Fundus photo, 2089x1764px — 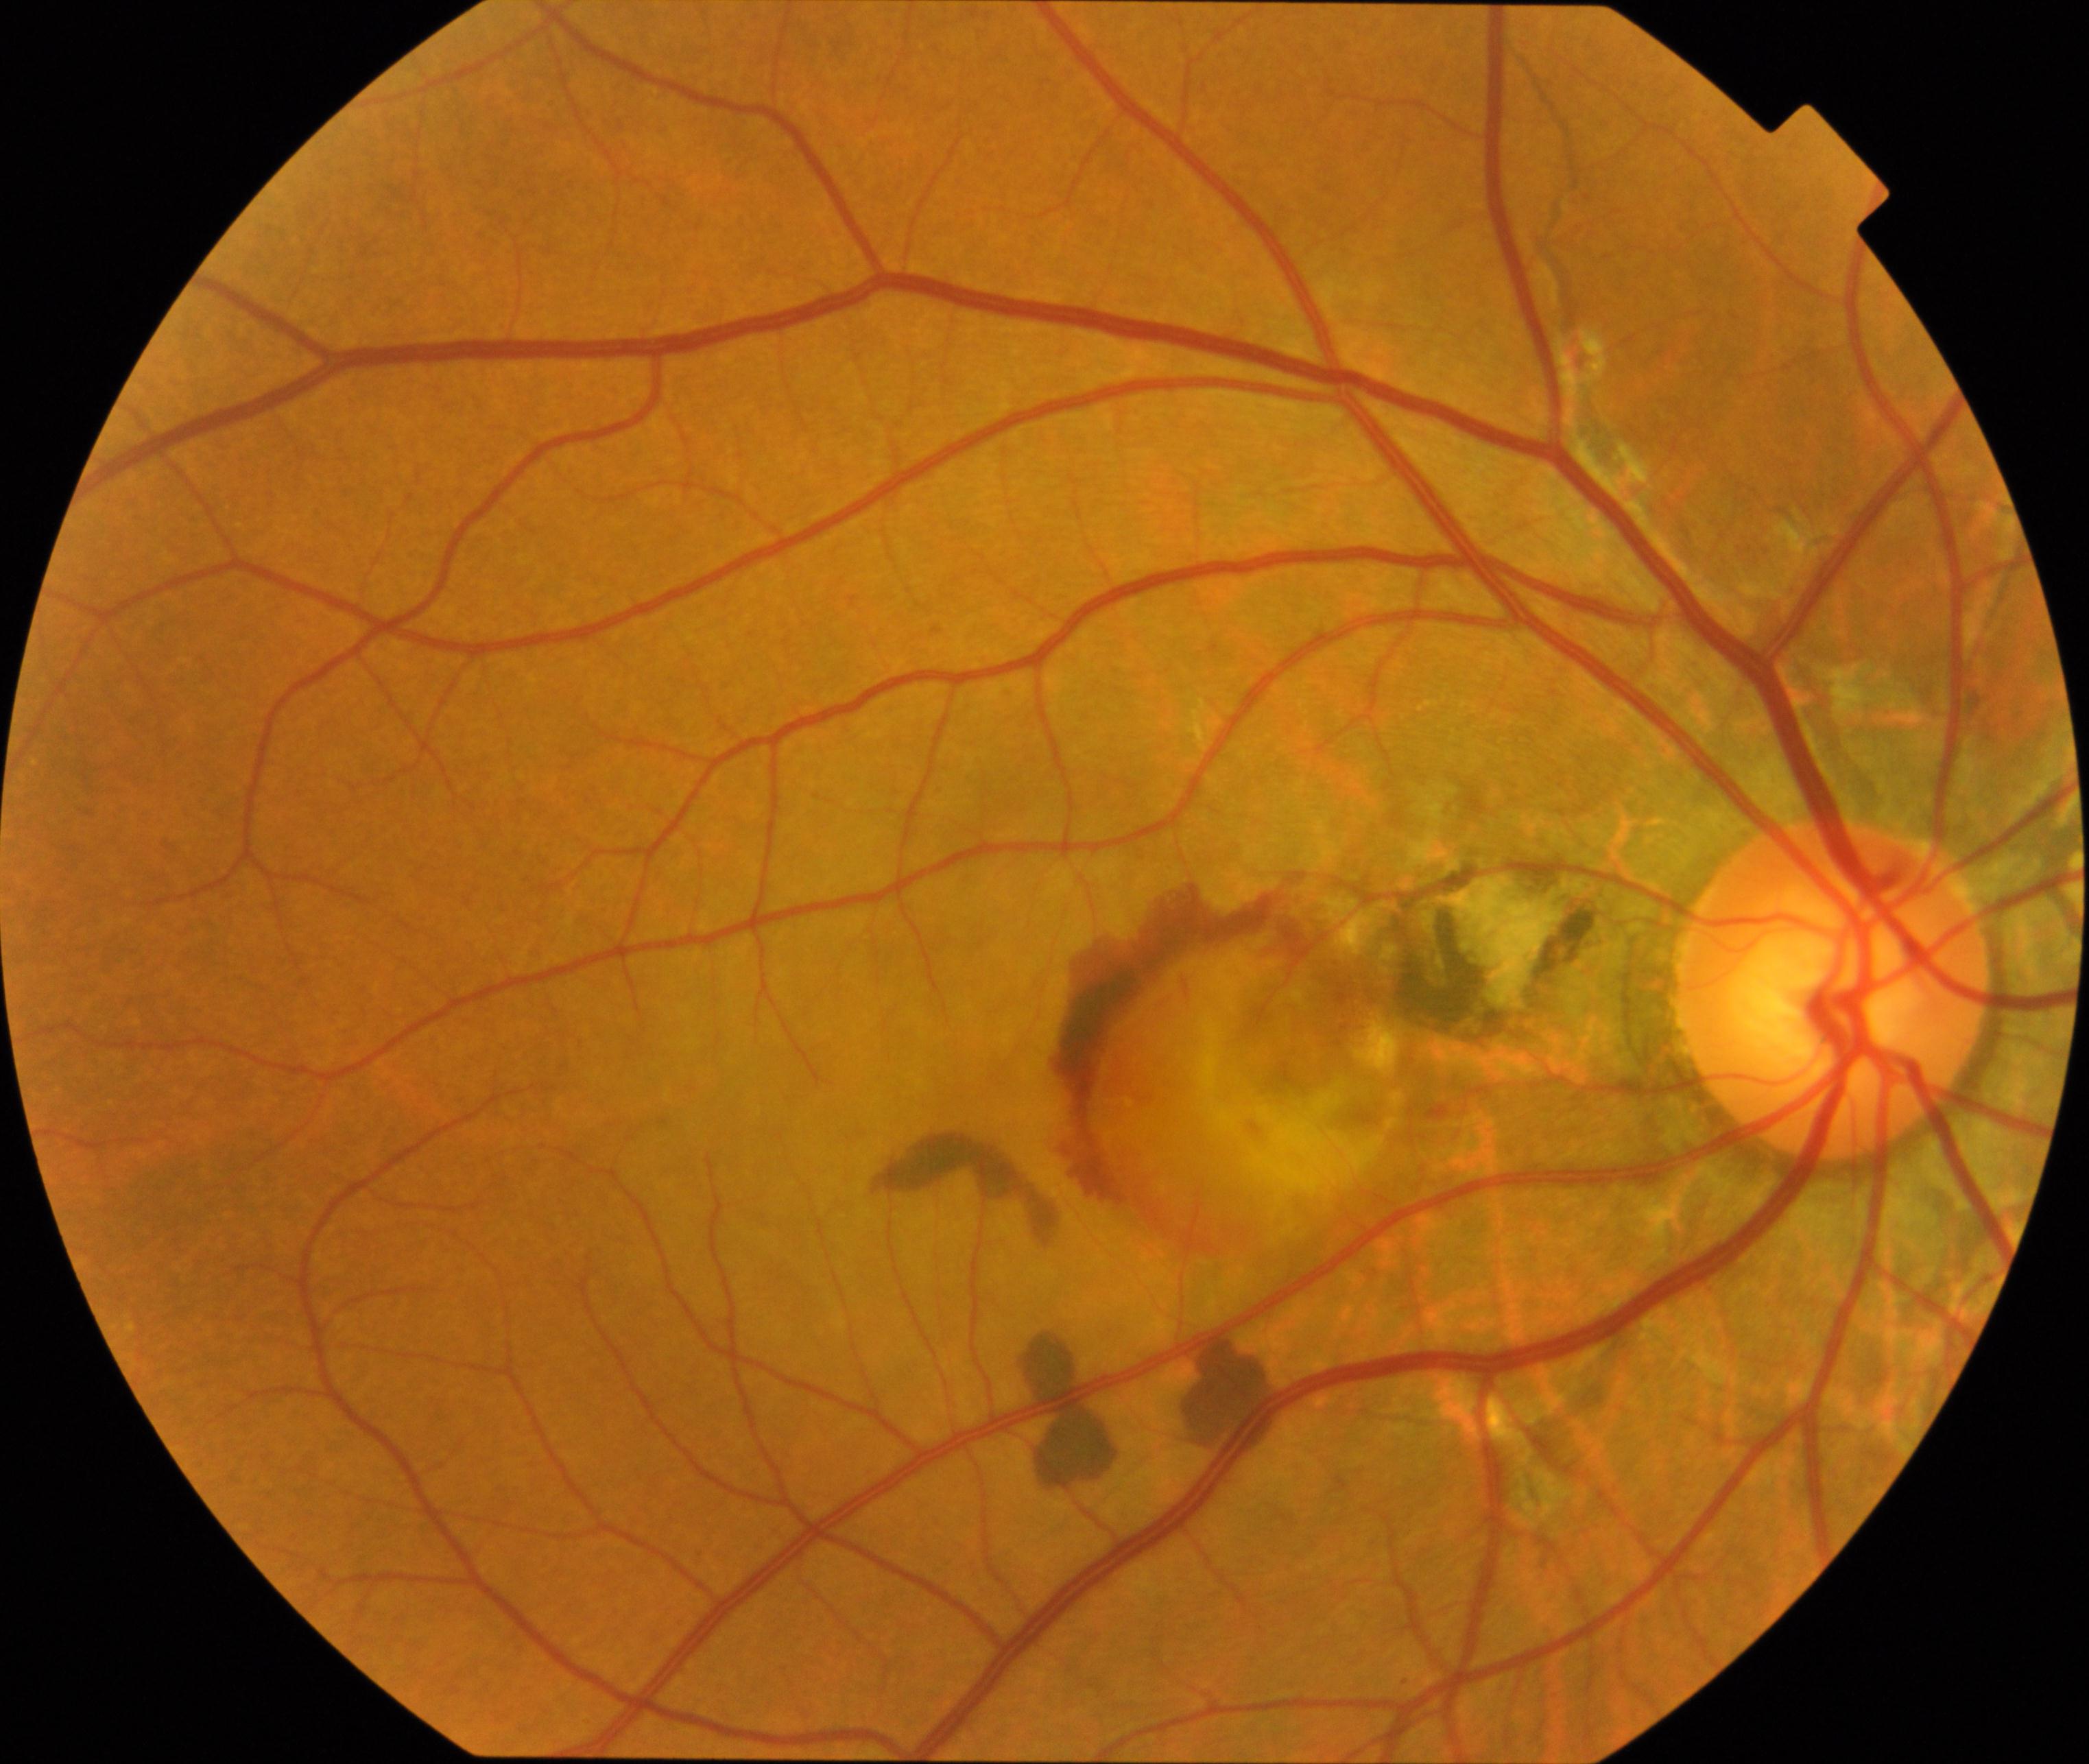 Diagnosis: maculopathy.